Camera: Phoenix ICON (100° FOV); infant wide-field retinal image; 1240 by 1240 pixels:
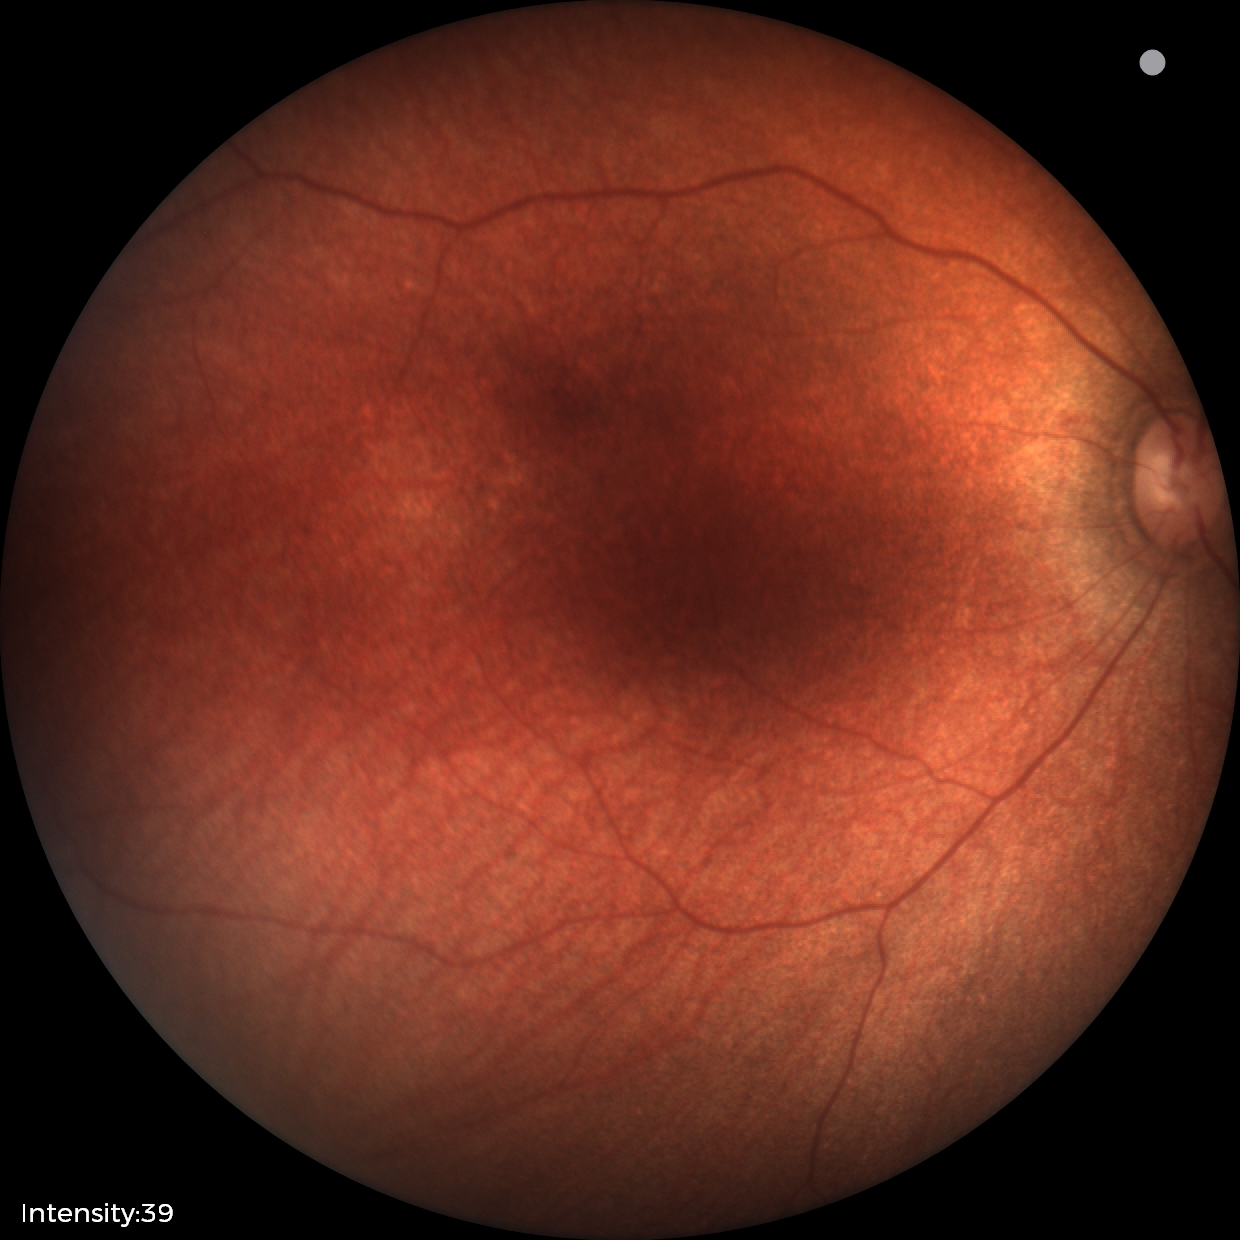

Screening diagnosis: physiological appearance.